Wide-field fundus image from infant ROP screening · 640x480px
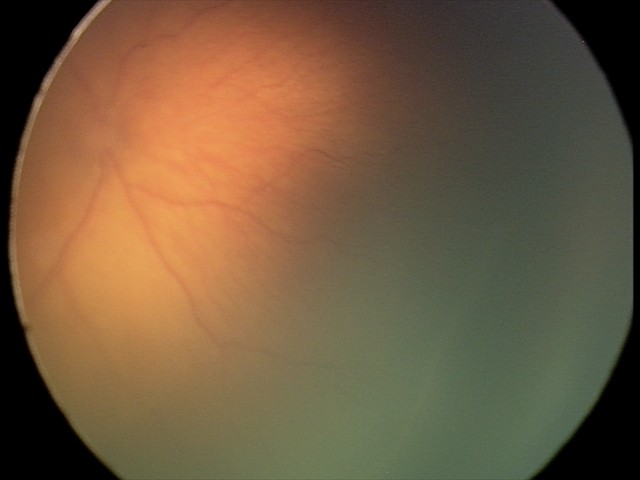 Without plus disease.
Examination diagnosed as retinopathy of prematurity stage 2 — ridge with height and width at the demarcation line.